Acquired on the Clarity RetCam 3; wide-field fundus image from infant ROP screening.
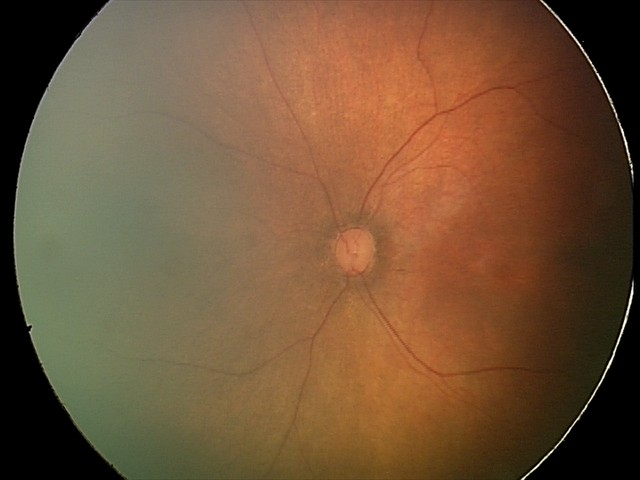

Impression: physiological retinal finding.